Graded on the modified Davis scale — 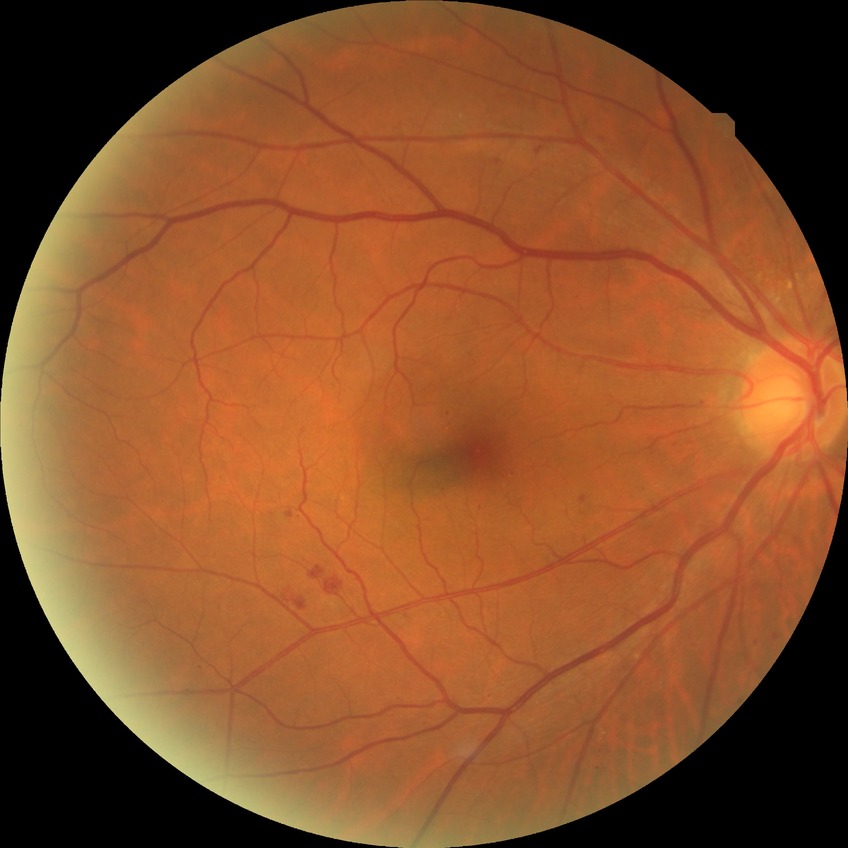
{
  "davis_grade": "SDR",
  "proliferative_class": "non-proliferative diabetic retinopathy"
}